640x480px; infant wide-field retinal image; 130° field of view (Clarity RetCam 3):
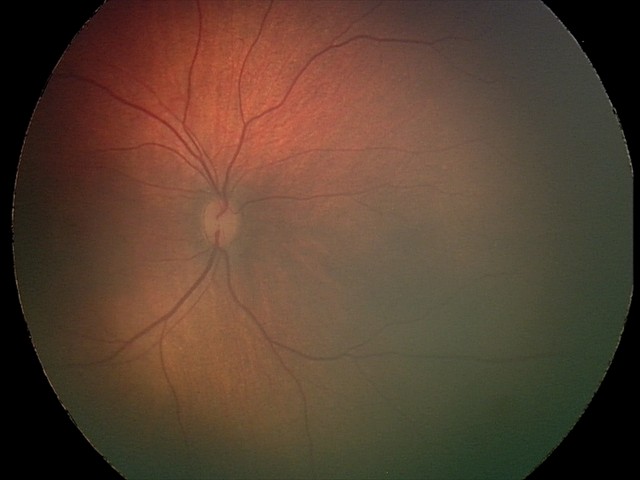

Screening: retinal hemorrhages.